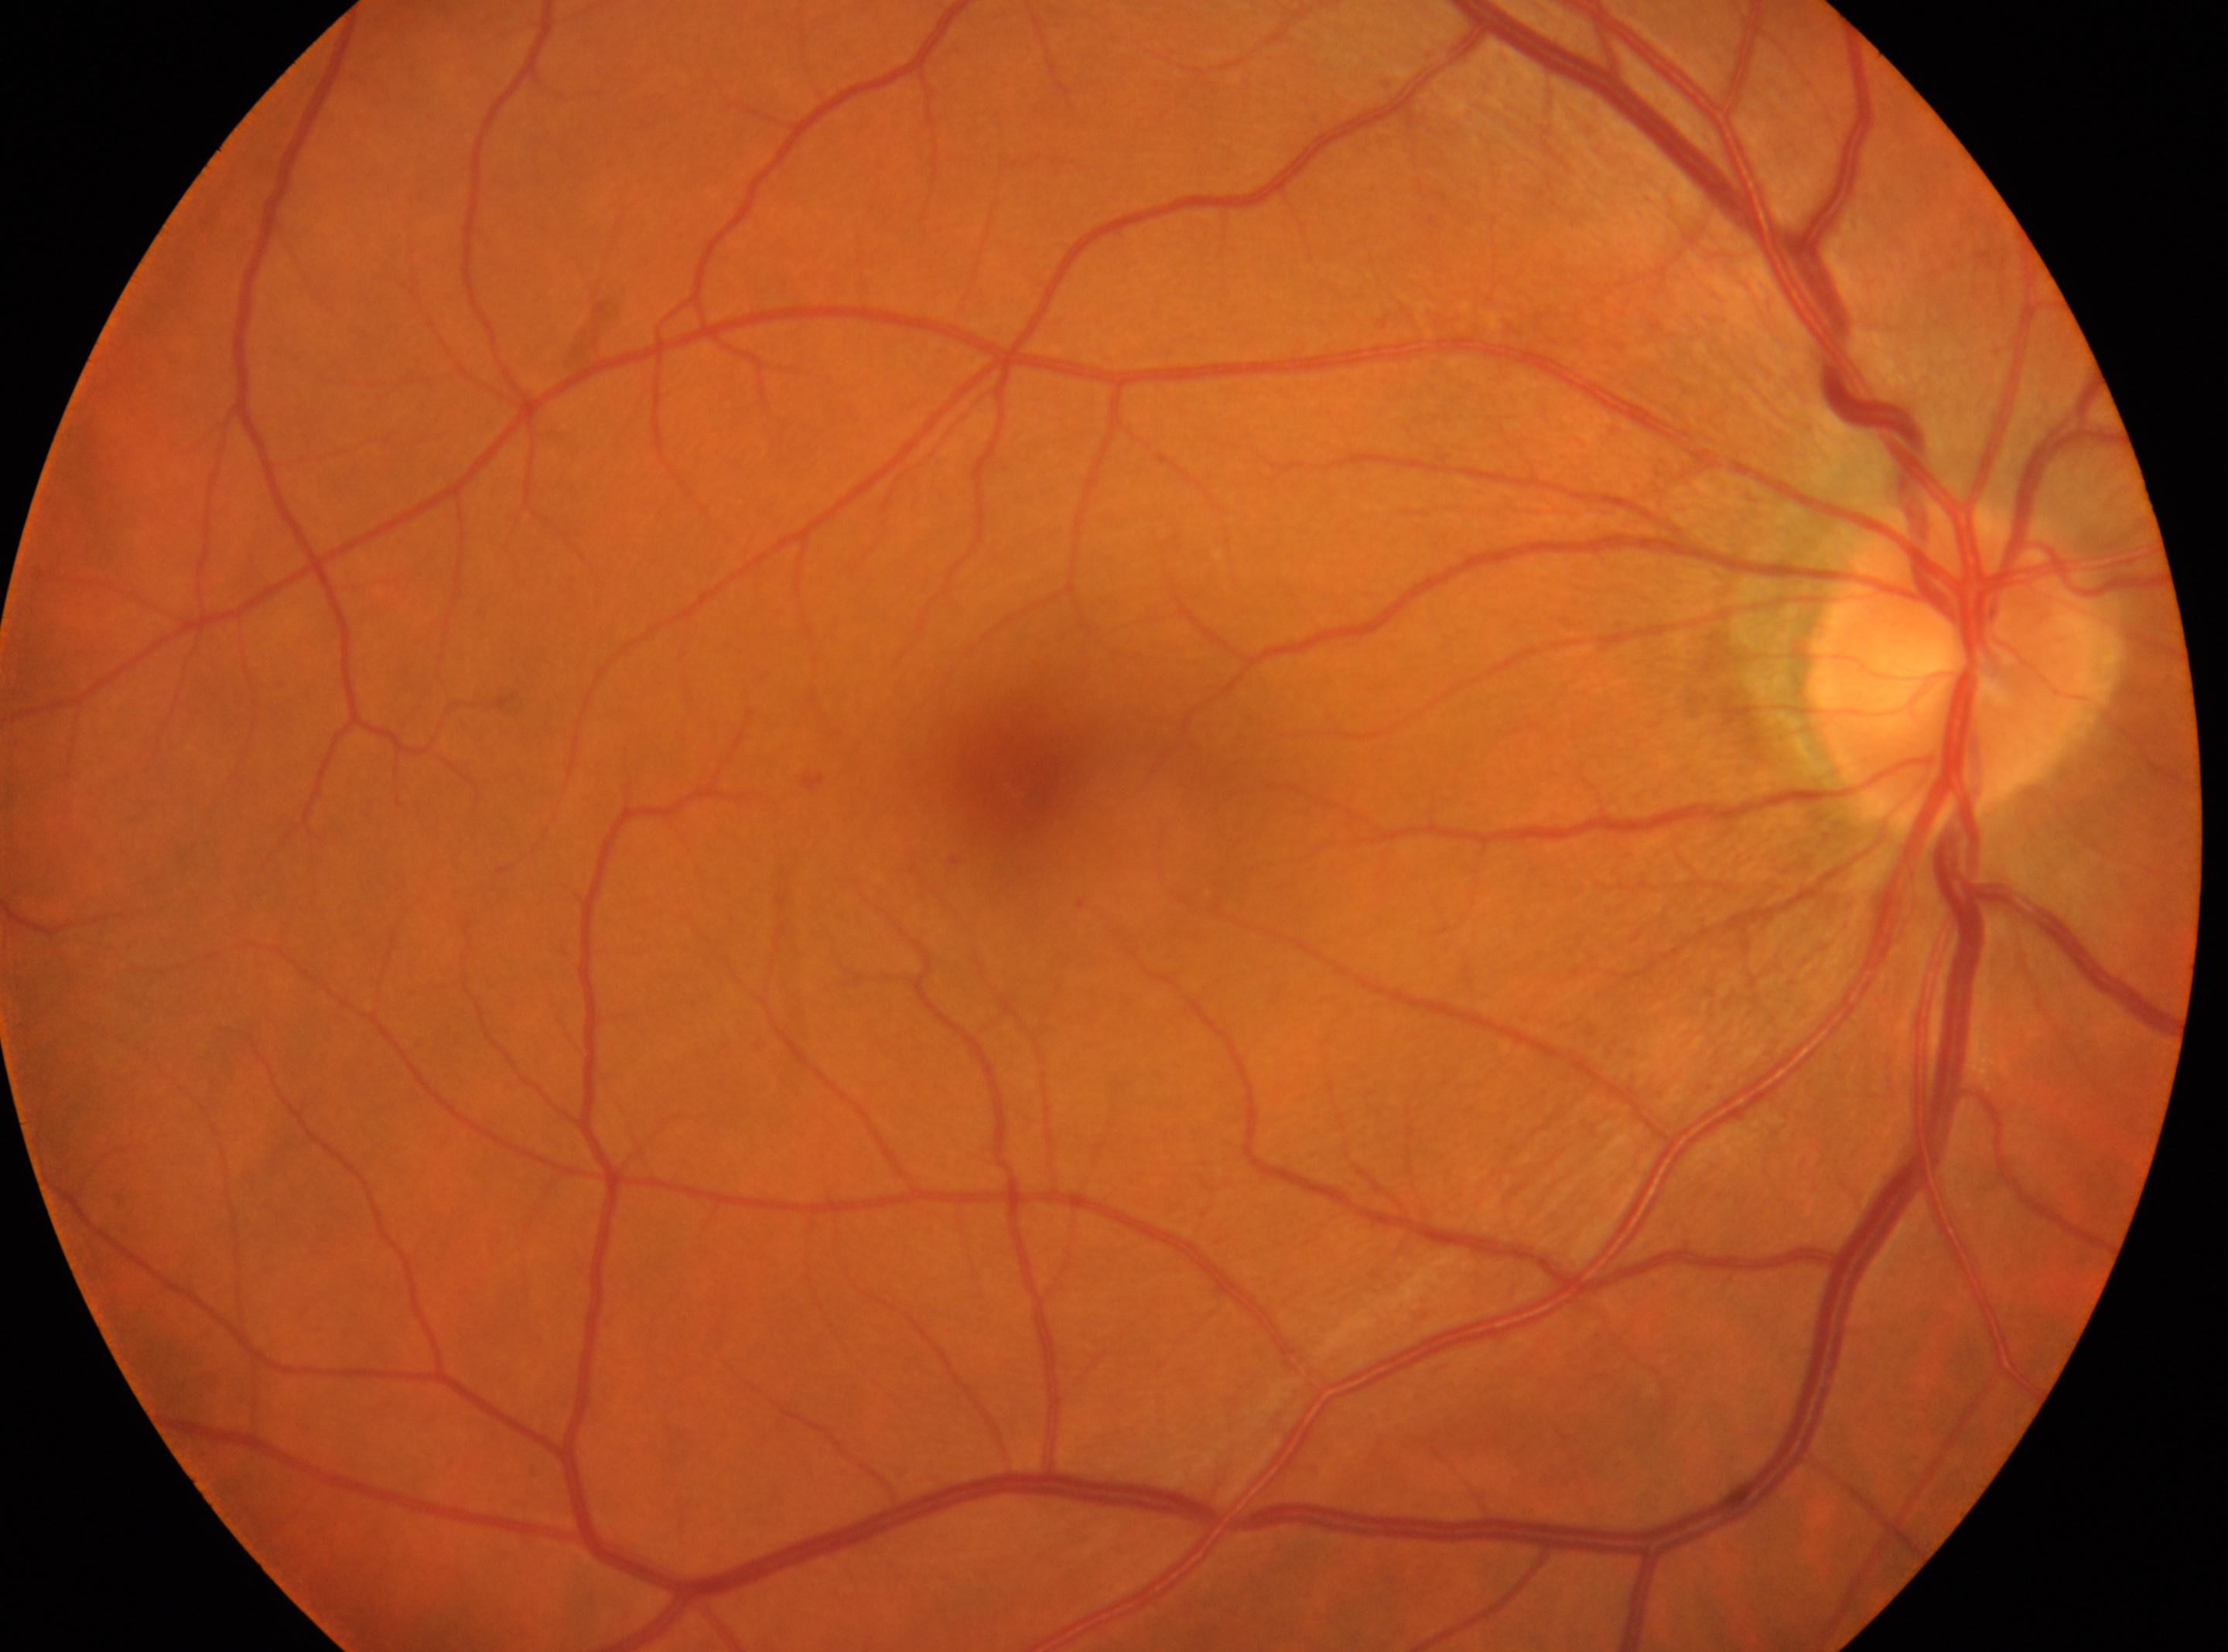

Eye: OD. Optic disc located at 1951, 667. Diabetic retinopathy (DR): grade 1 (mild NPDR). Foveal center: 1029, 797.